FOV: 50 degrees. Color fundus photograph — 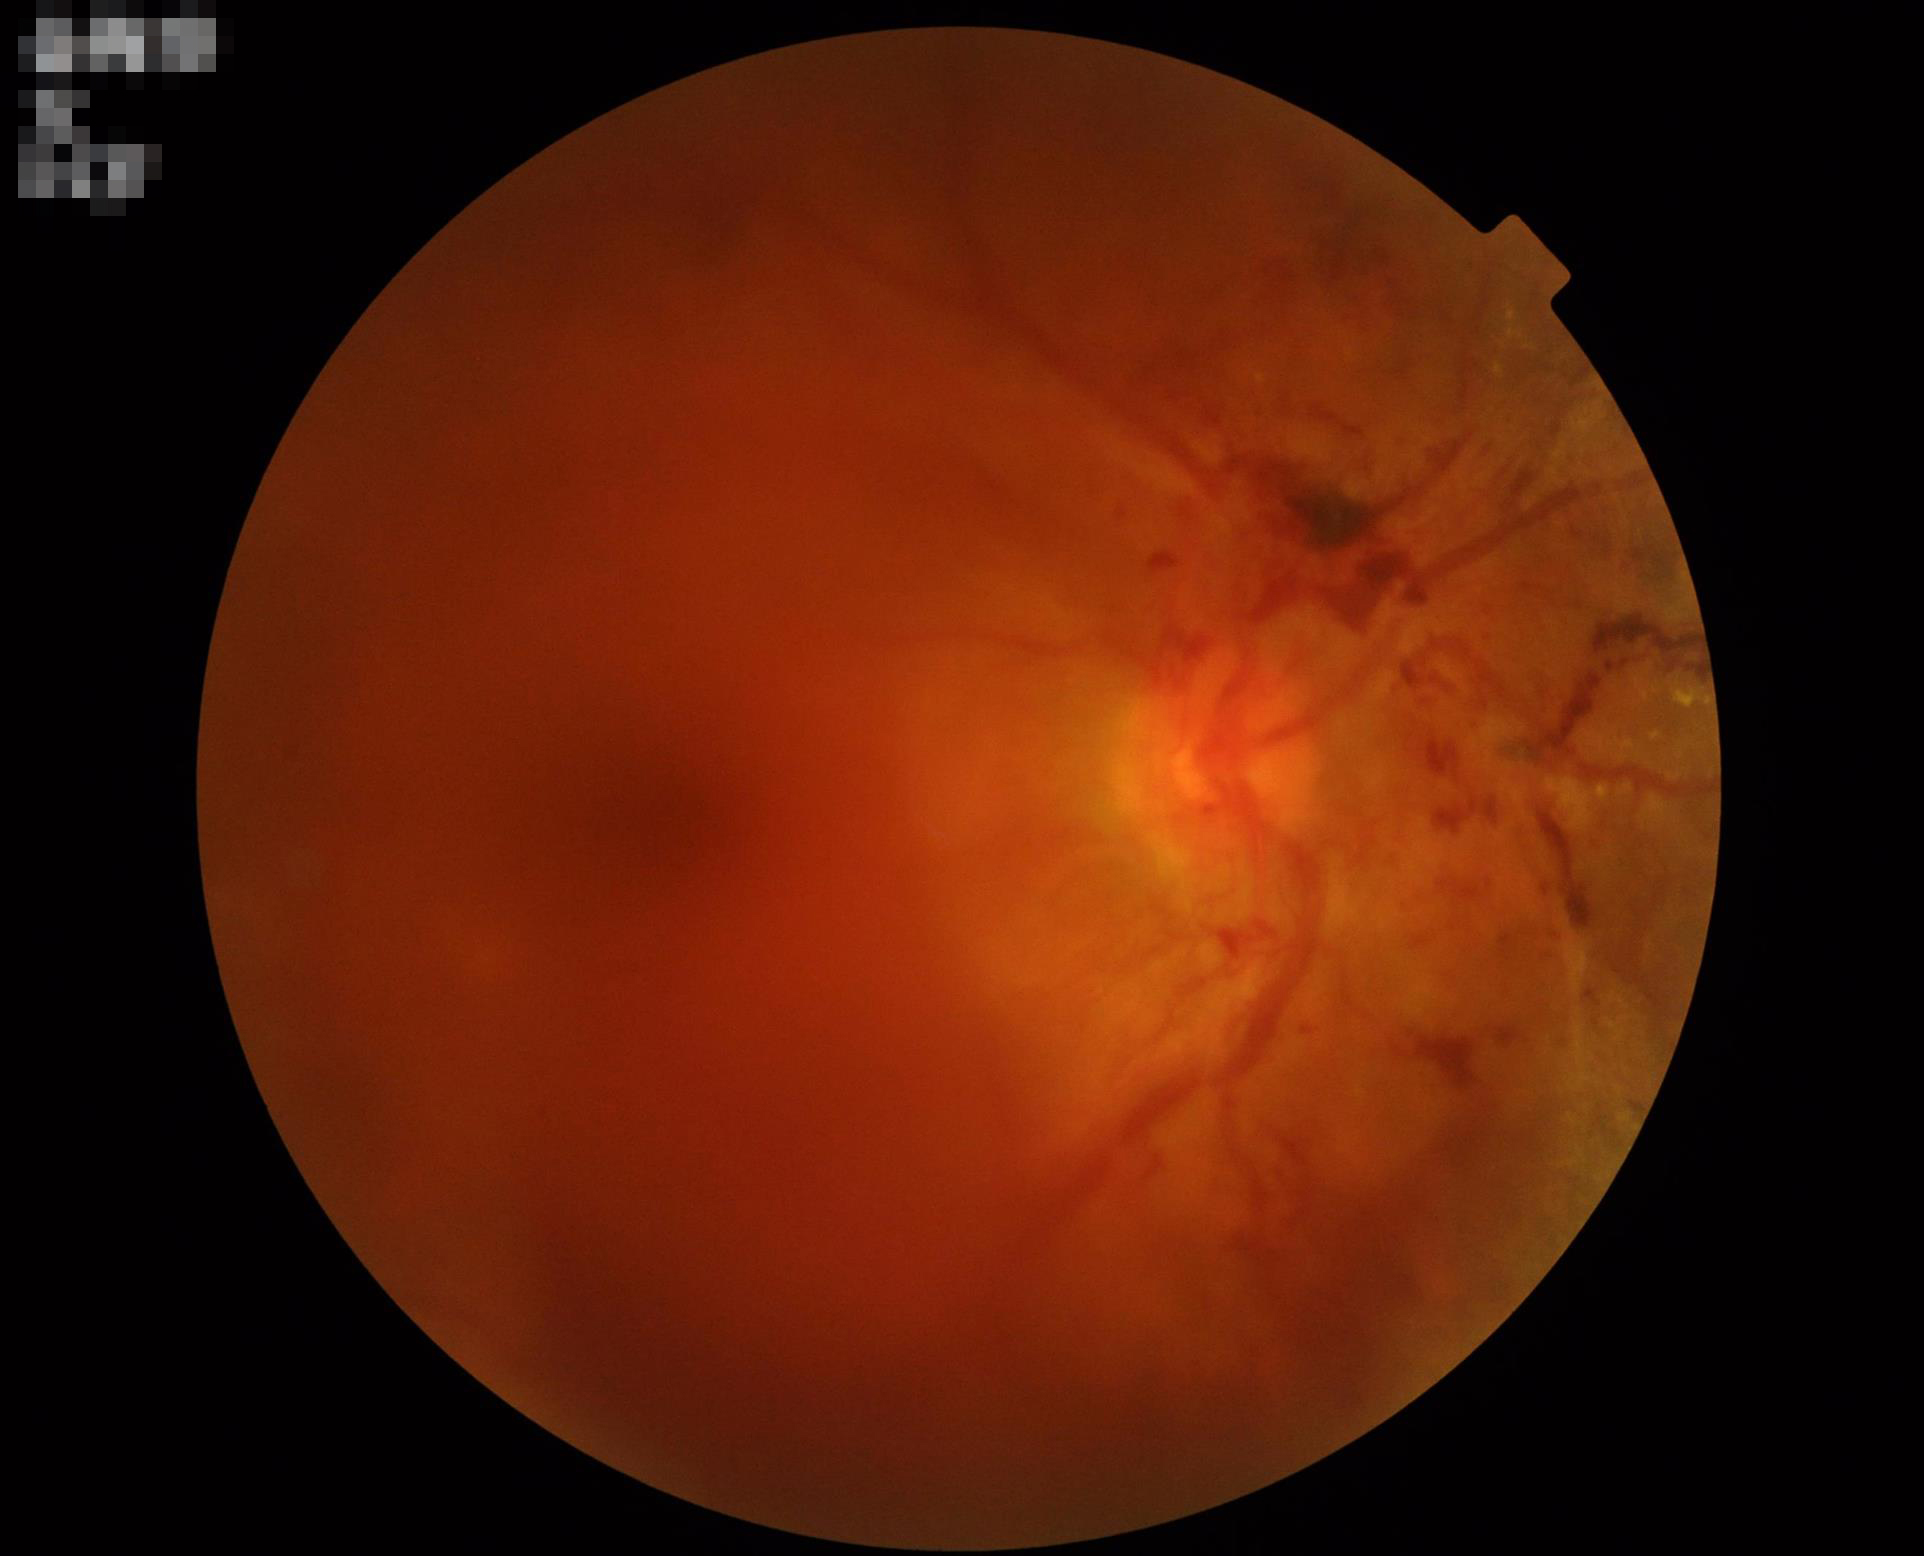

{
  "contrast": "poor dynamic range",
  "overall_quality": "poor, ungradable",
  "illumination": "no over- or under-exposure",
  "clarity": "noticeable blur in the optic disc, vessels, or background"
}